Modified Davis grading
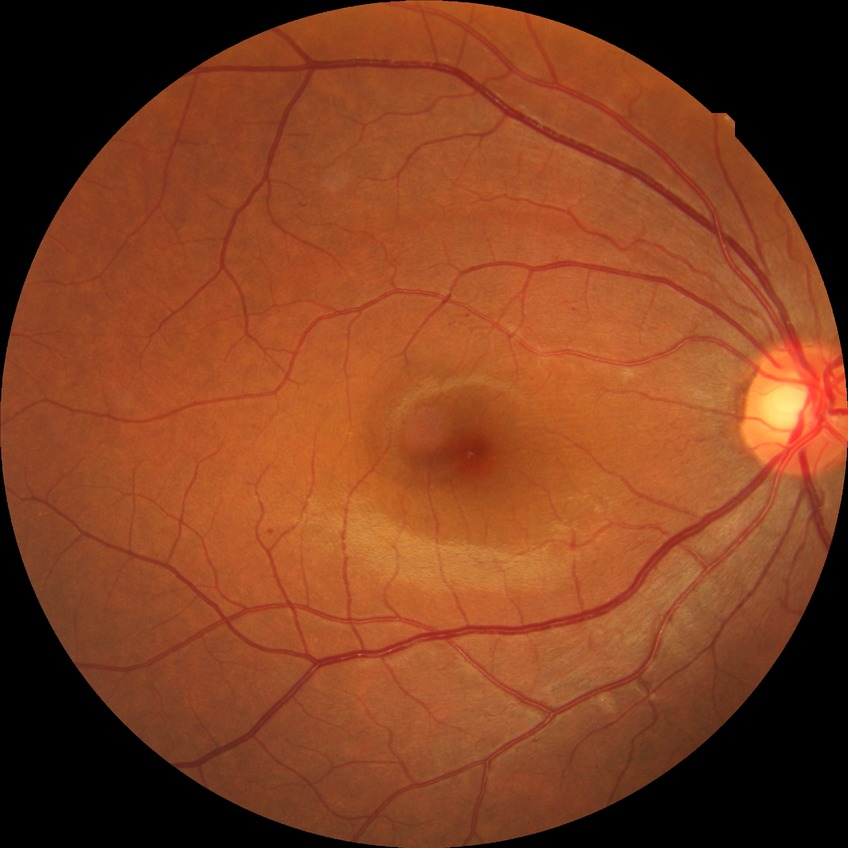

Findings:
- diabetic retinopathy (DR) — SDR (simple diabetic retinopathy)